Ultra-widefield (UWF) fundus image:
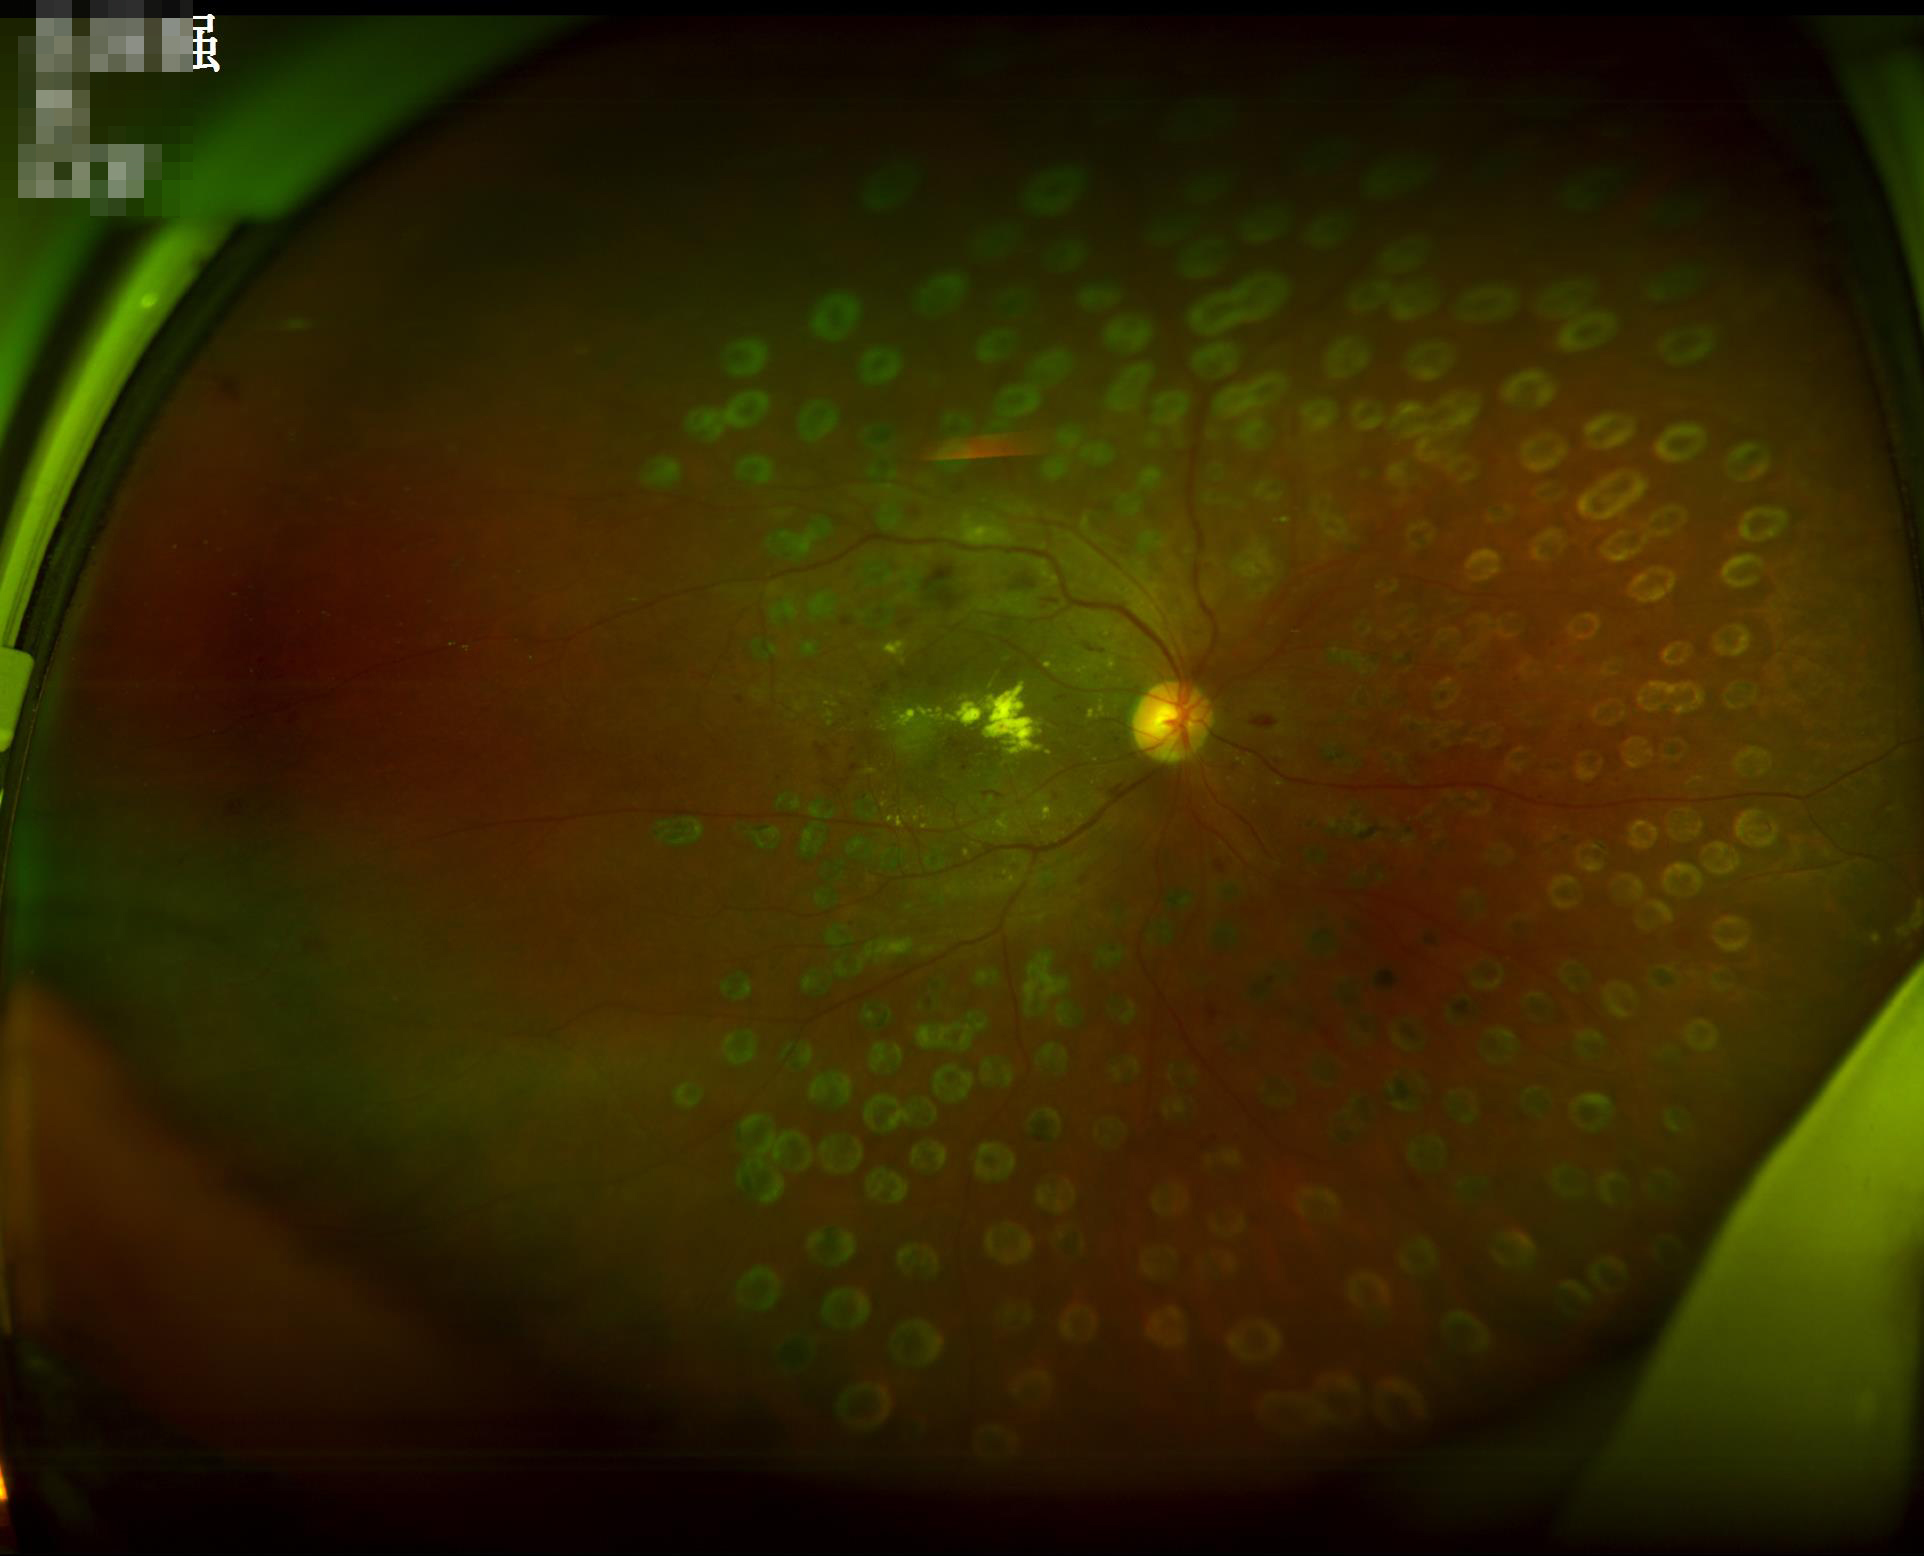
Image quality is suboptimal.
Illumination and color are suboptimal.